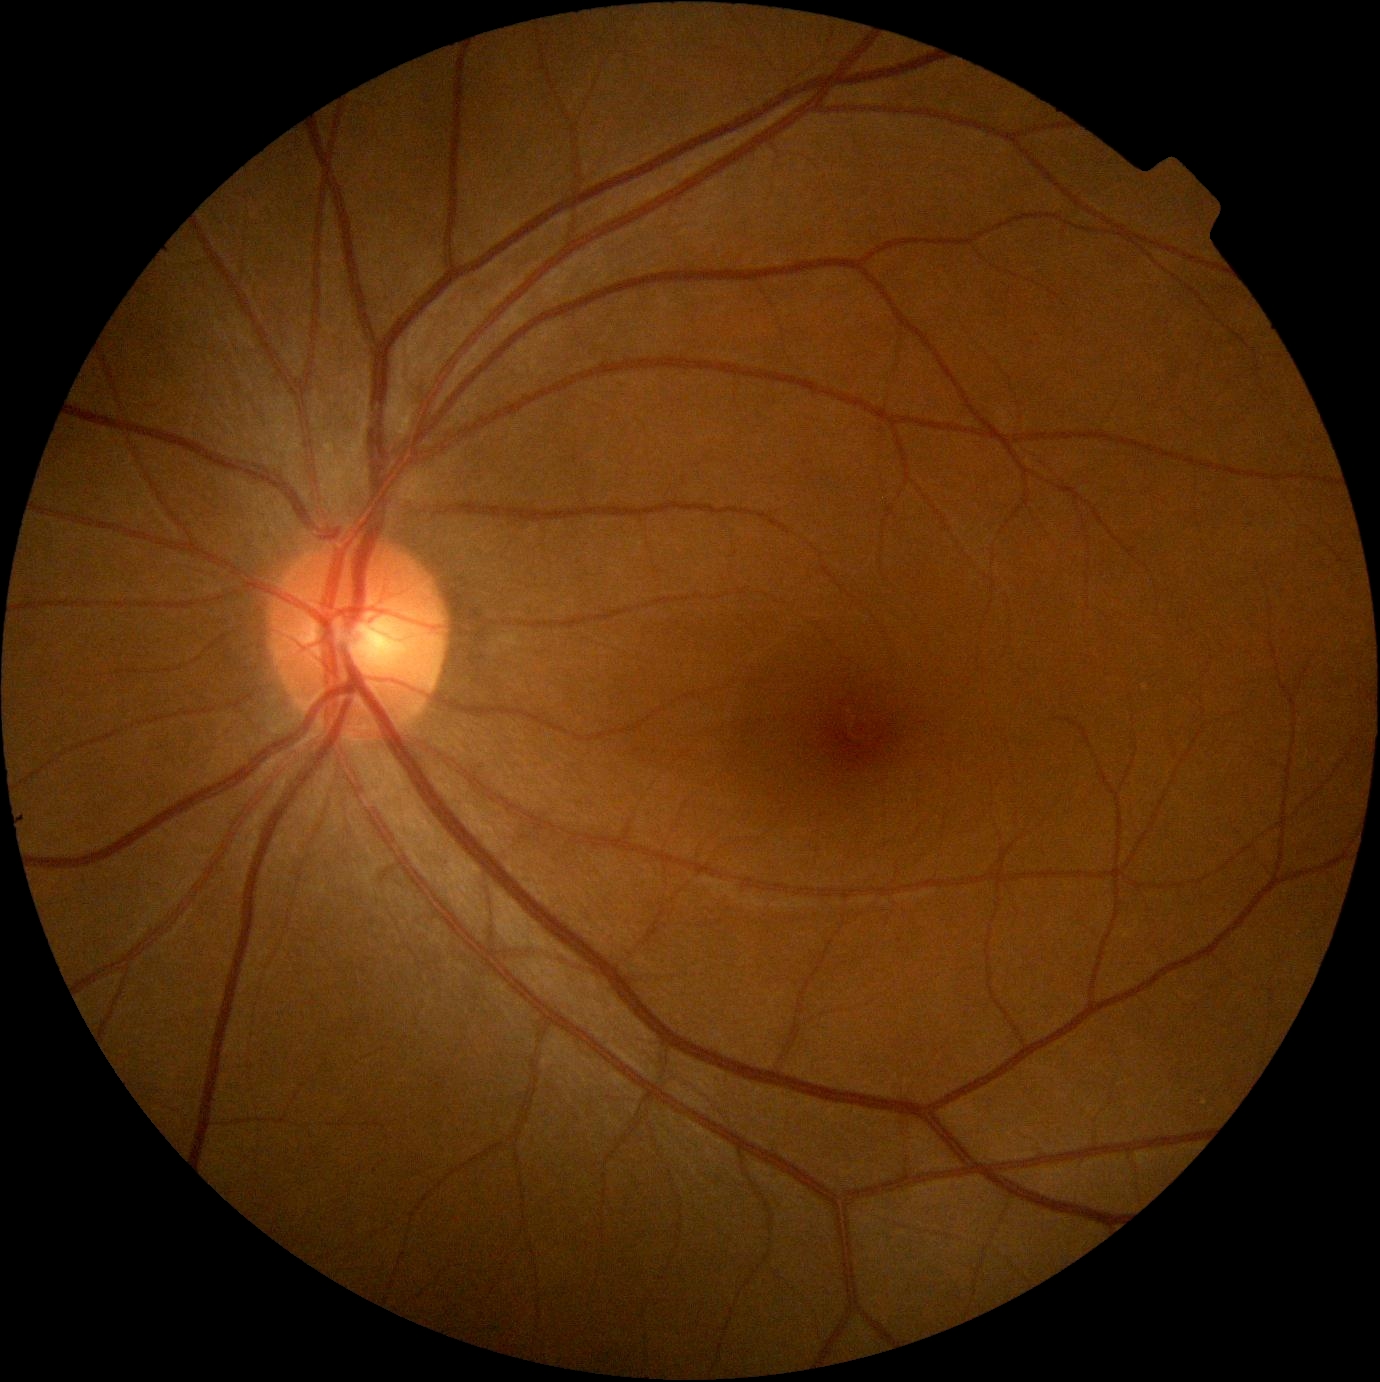

{
  "dr_grade": "0/4"
}